Wide-field fundus photograph of an infant; 1240x1240px — 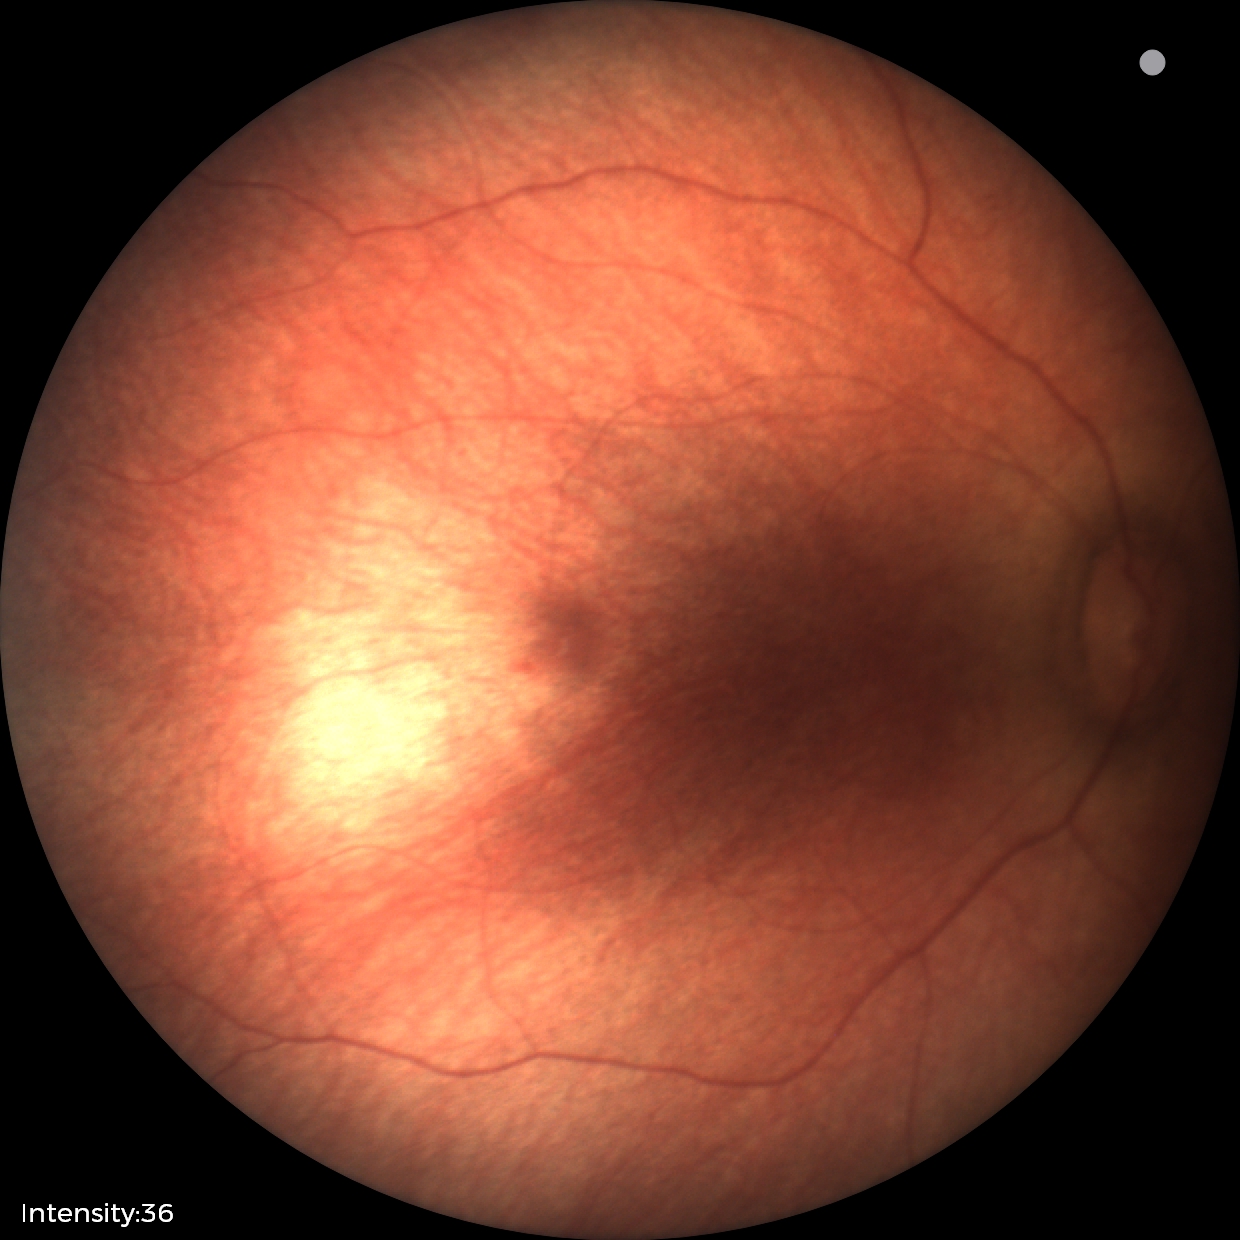

Screening: normal fundus examination.